Modified Davis grading
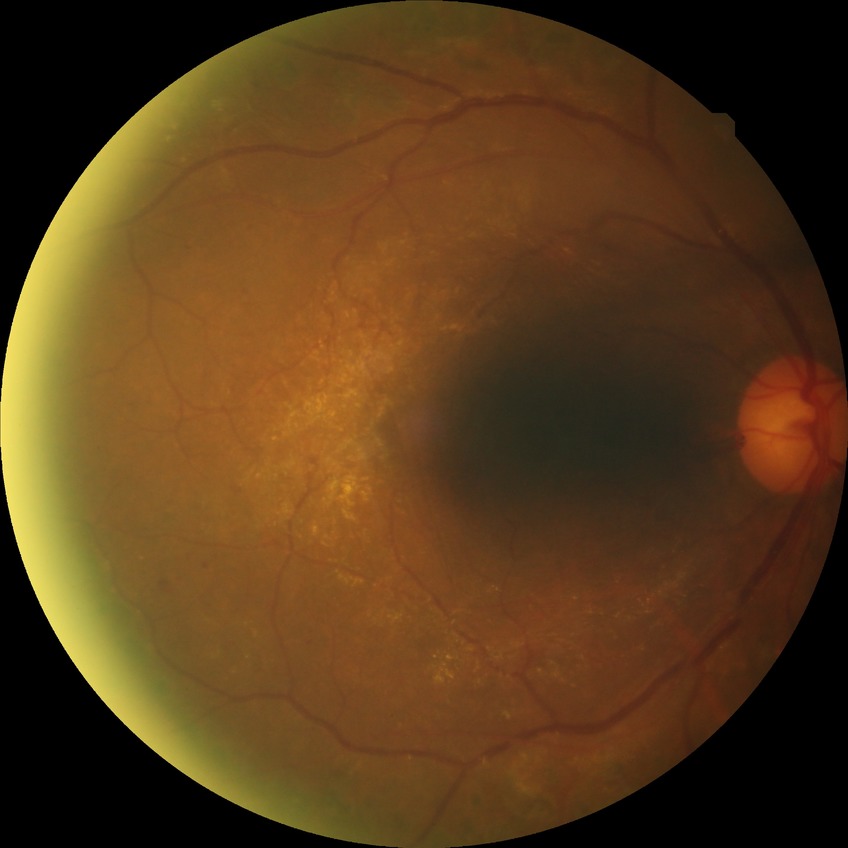
Diabetic retinopathy stage is proliferative diabetic retinopathy.